Camera: NIDEK AFC-230; color fundus image; modified Davis grading; 45 degree fundus photograph: 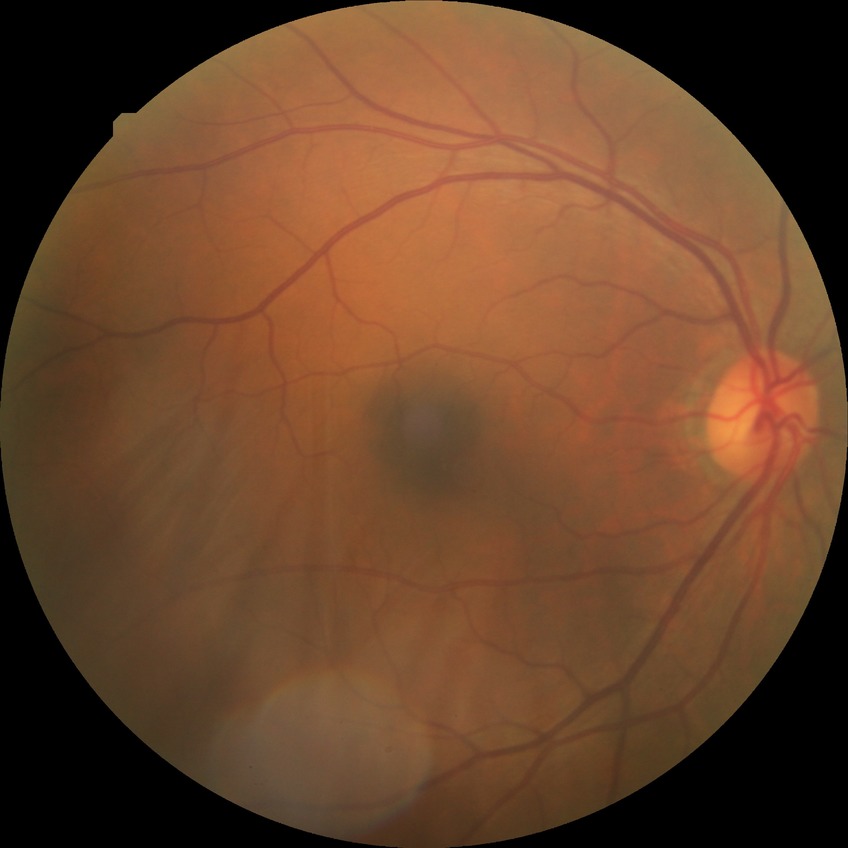 DR grade: NDR.